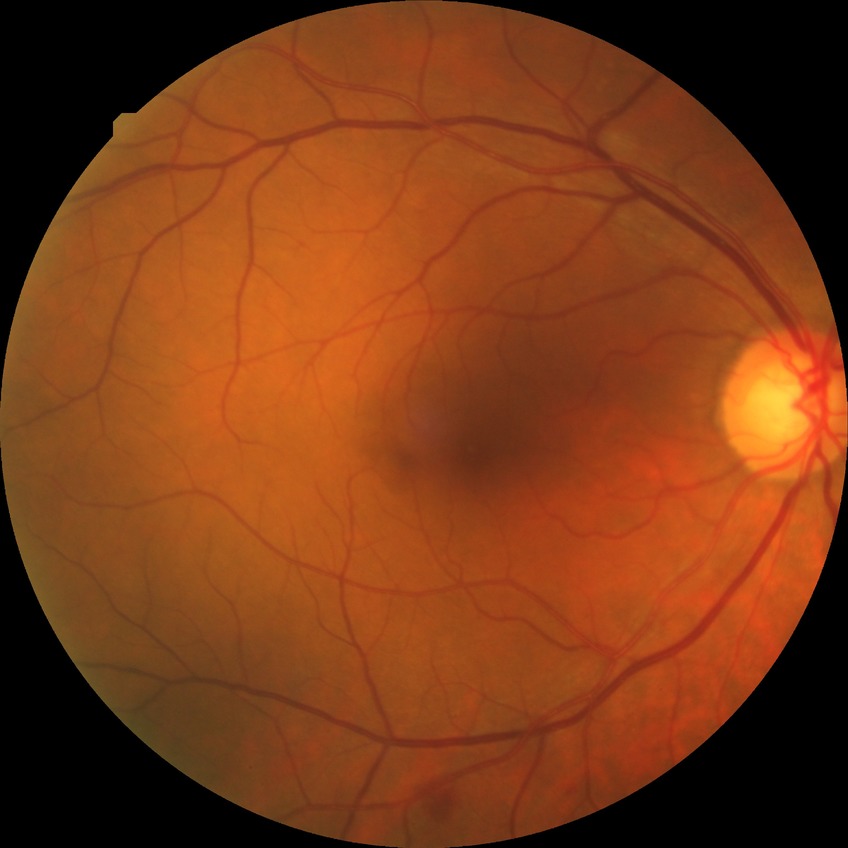
Diabetic retinopathy (DR): simple diabetic retinopathy (SDR).